2352 by 1568 pixels · CFP
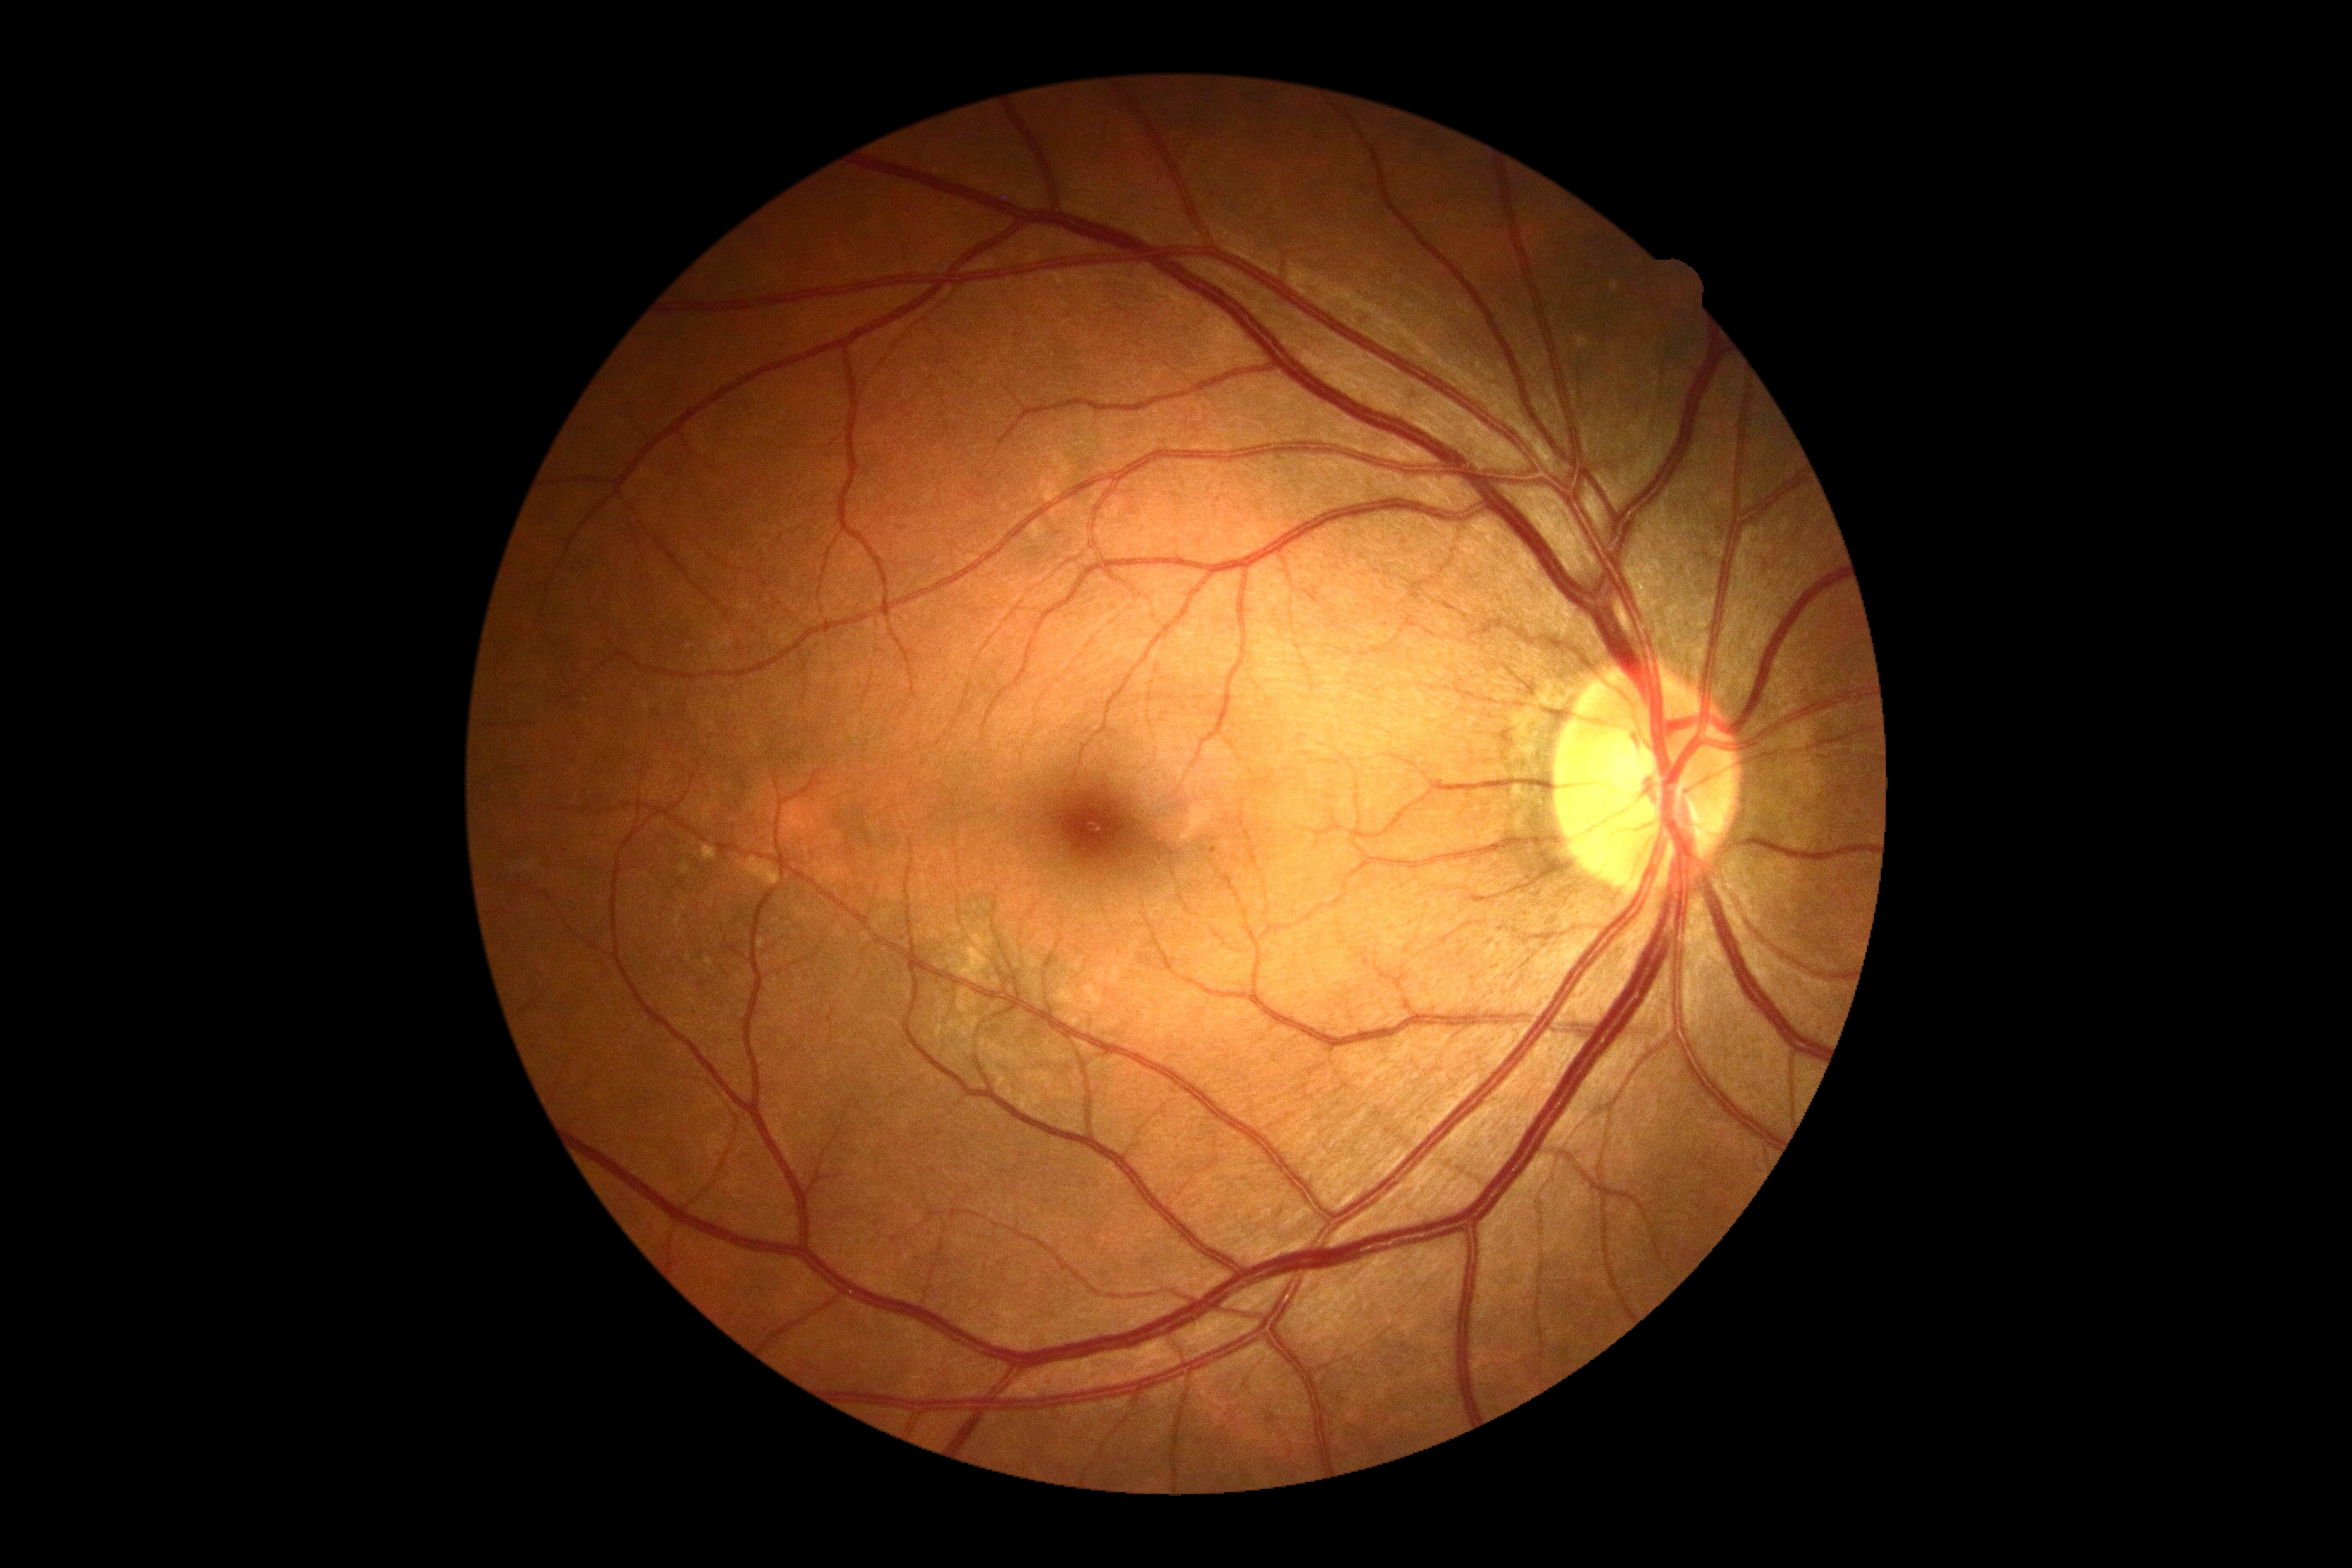
Diabetic retinopathy (DR) is grade 0.
No signs of diabetic retinopathy.